Color fundus image; camera: NIDEK AFC-230; without pupil dilation; 848 by 848 pixels; 45-degree field of view
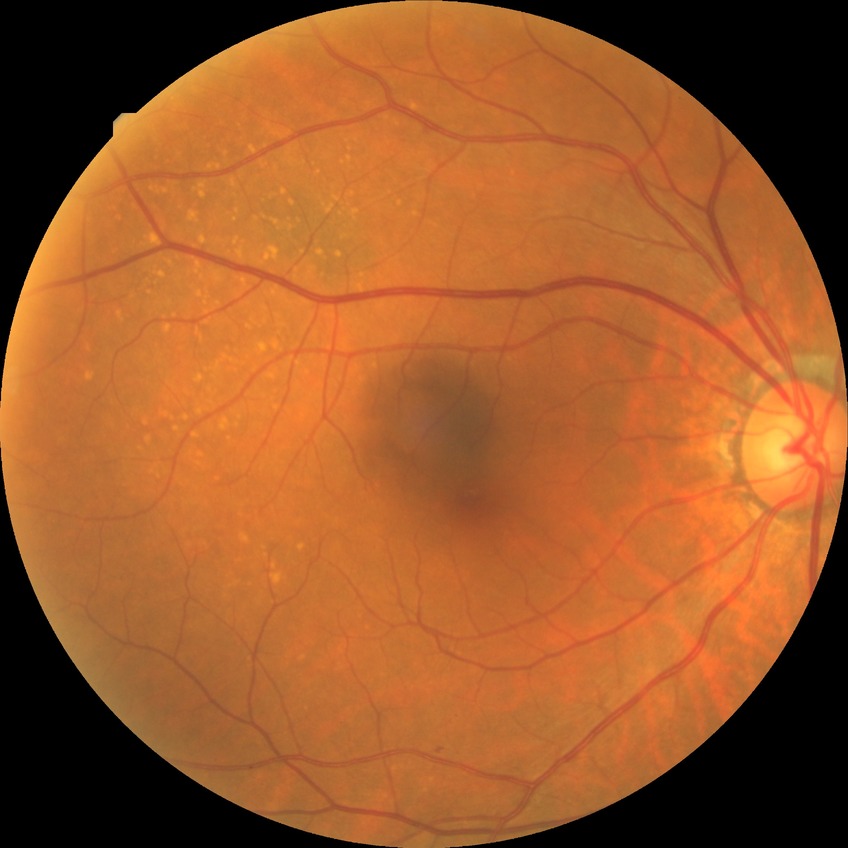 Diabetic retinopathy (DR) is simple diabetic retinopathy (SDR).